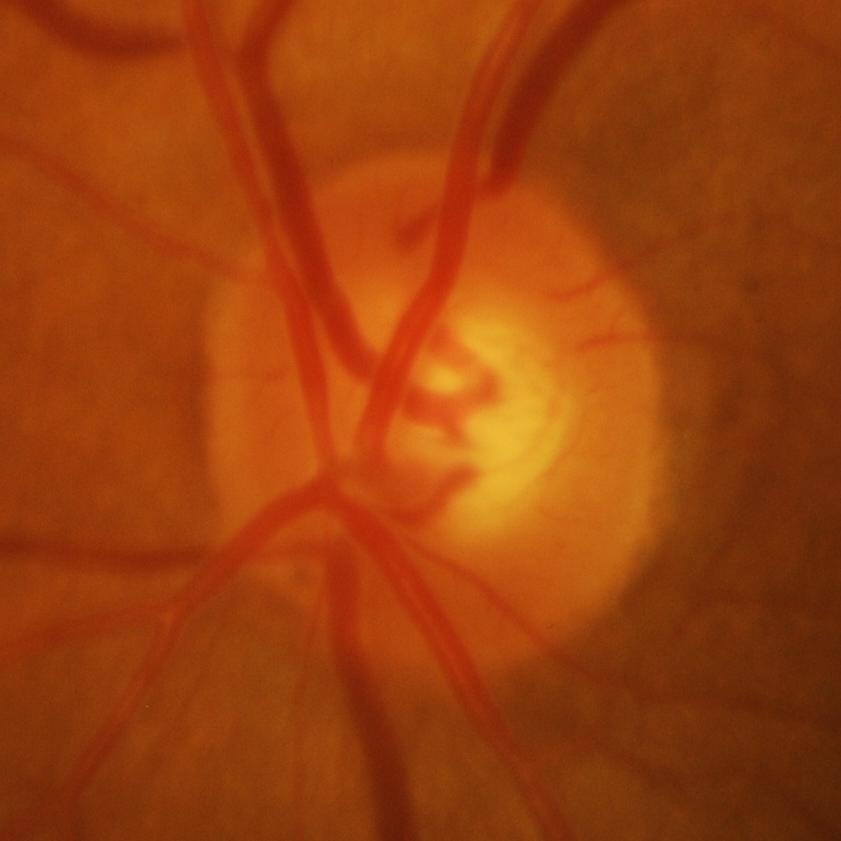

Glaucoma status = glaucomatous findings.